100° field of view (Phoenix ICON); wide-field fundus image from infant ROP screening
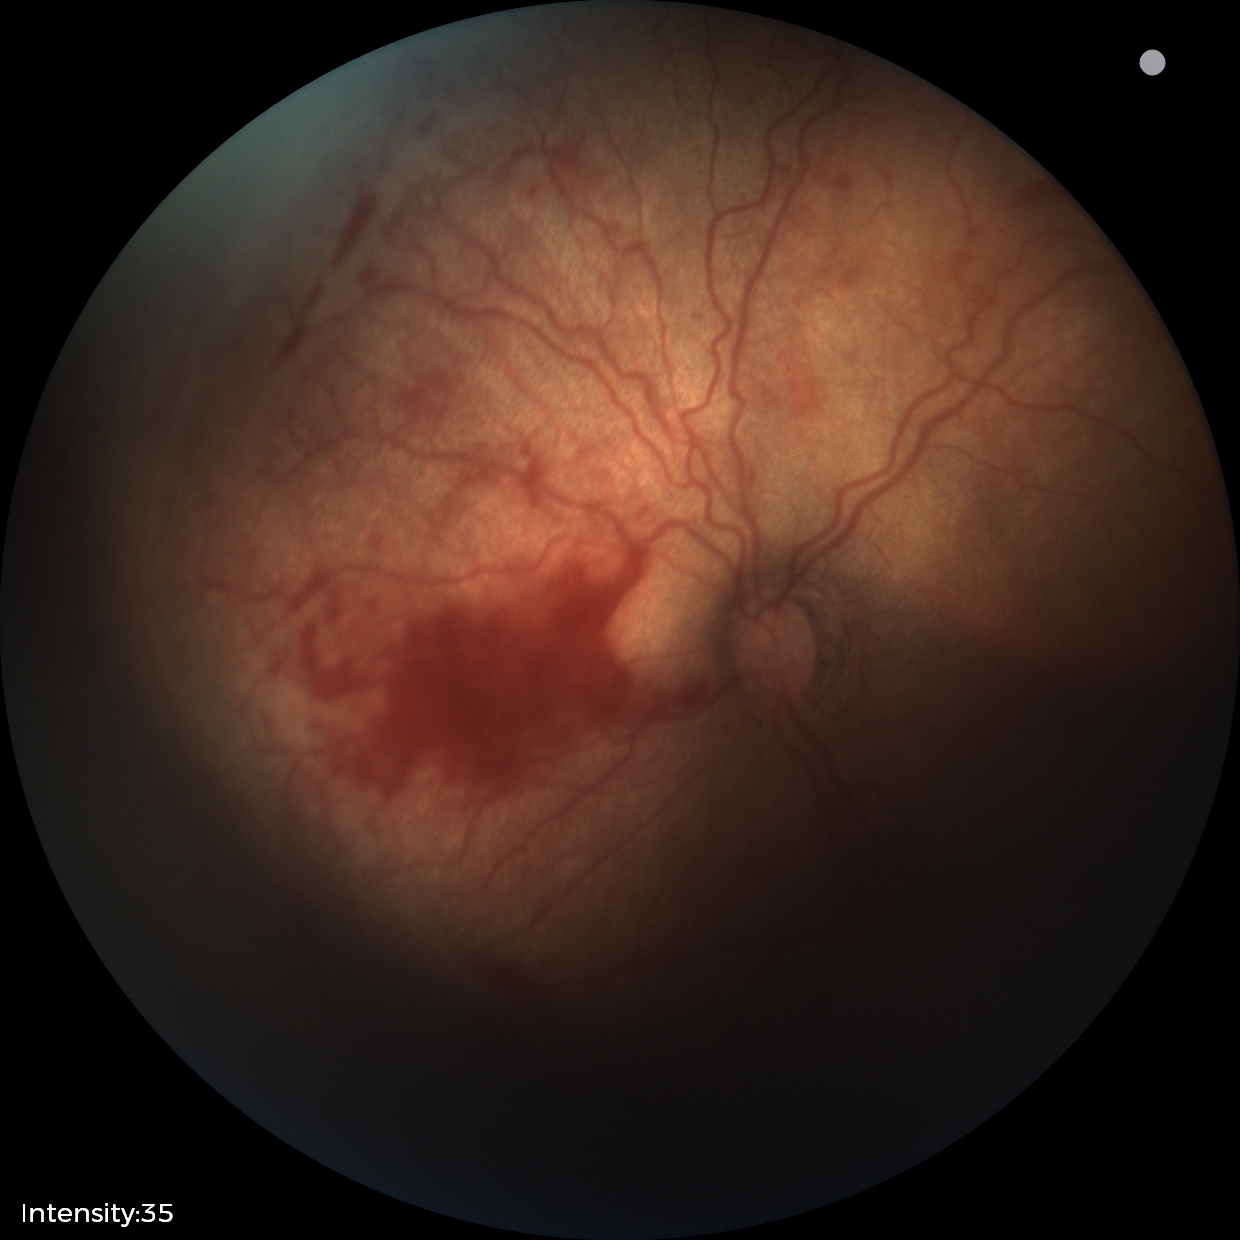
Screening diagnosis: retinopathy of prematurity stage 2.